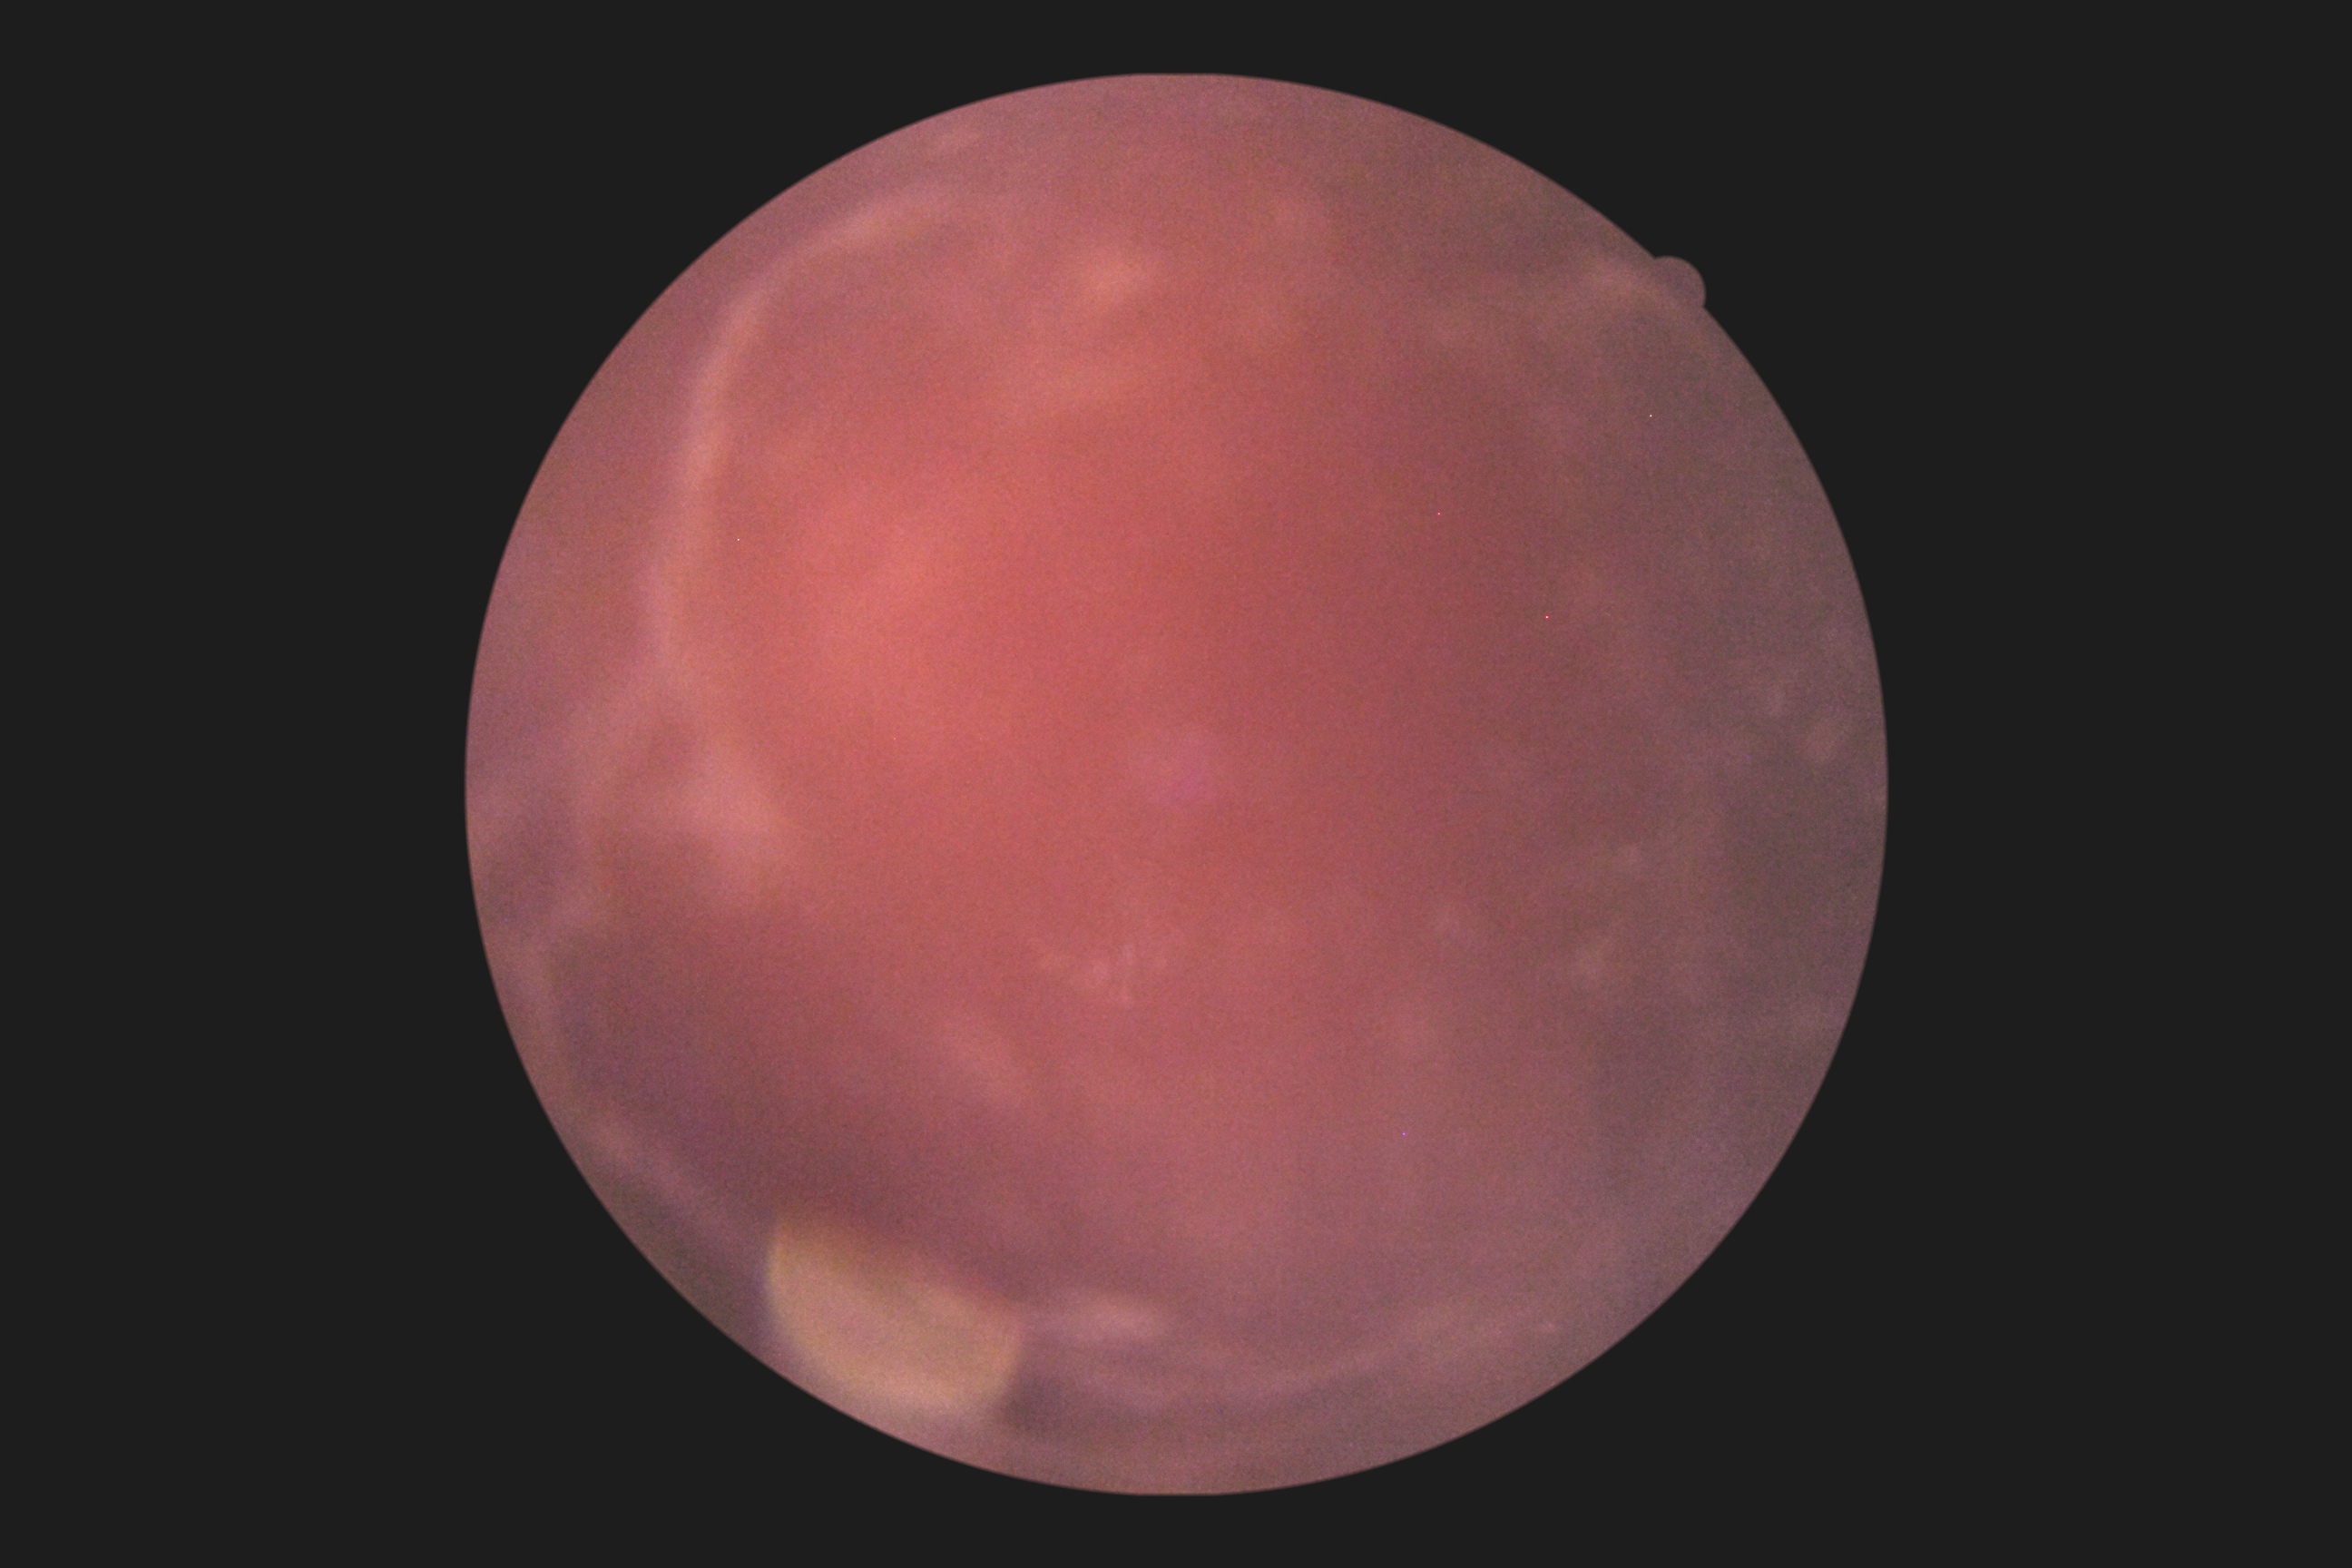

image quality=too poor for DR grading; diabetic retinopathy (DR)=ungradable.